Phoenix ICON, 100° FOV · 1240x1240 · wide-field fundus photograph of an infant — 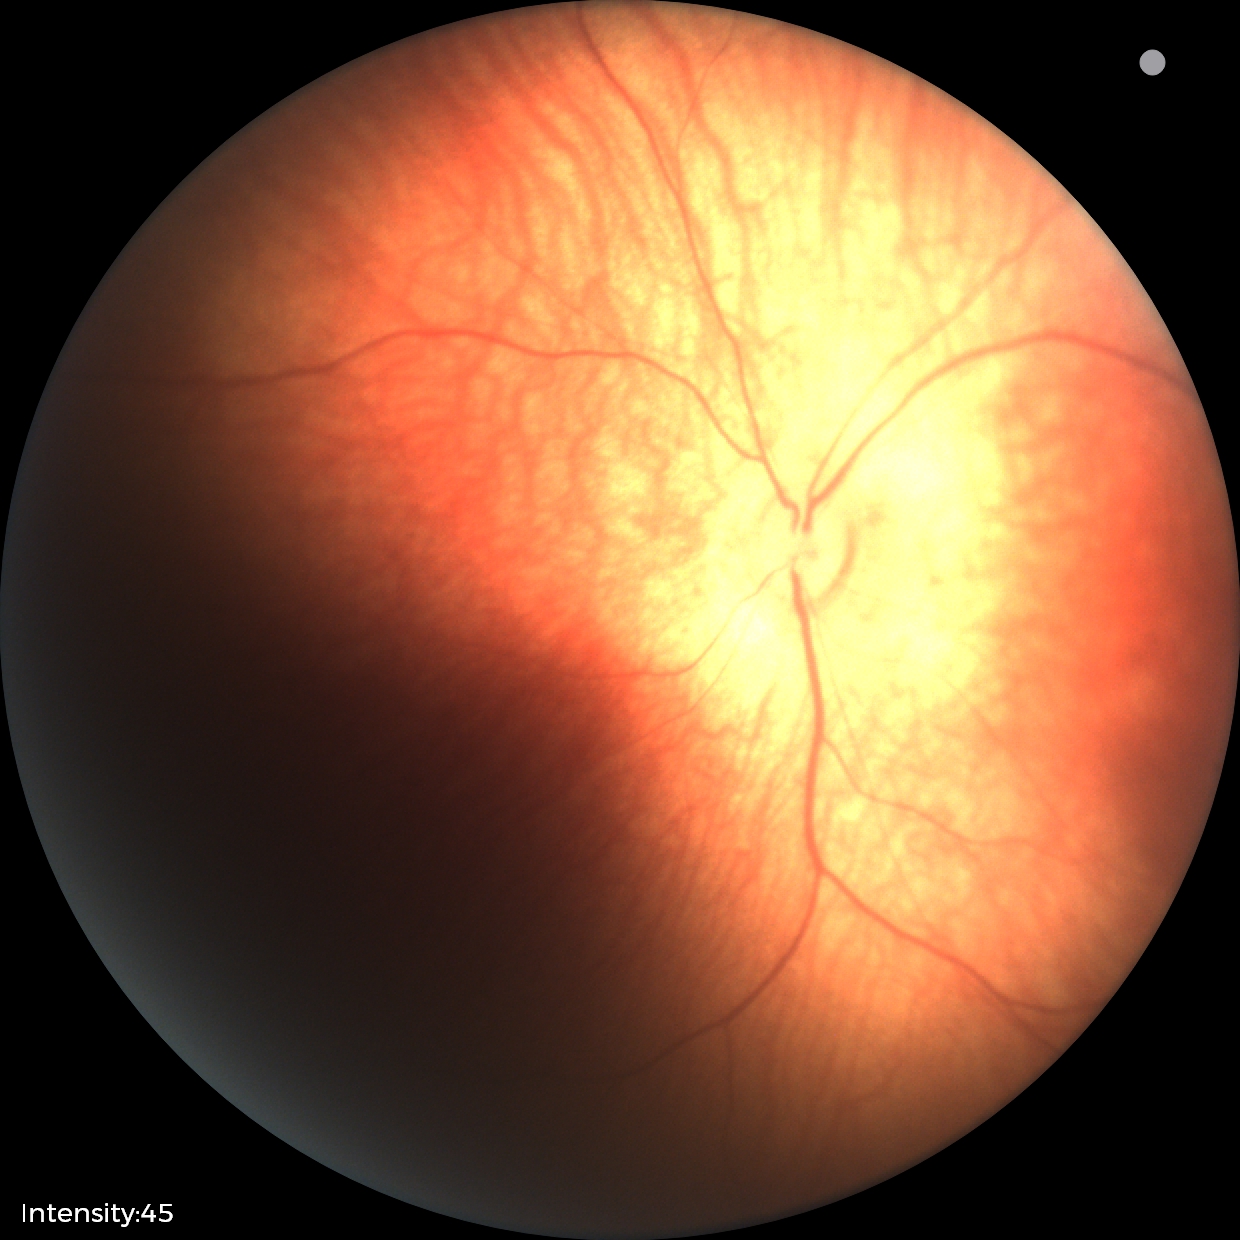 No retinal pathology identified on screening.